Posterior pole view; 2228x1652px; color fundus photograph.
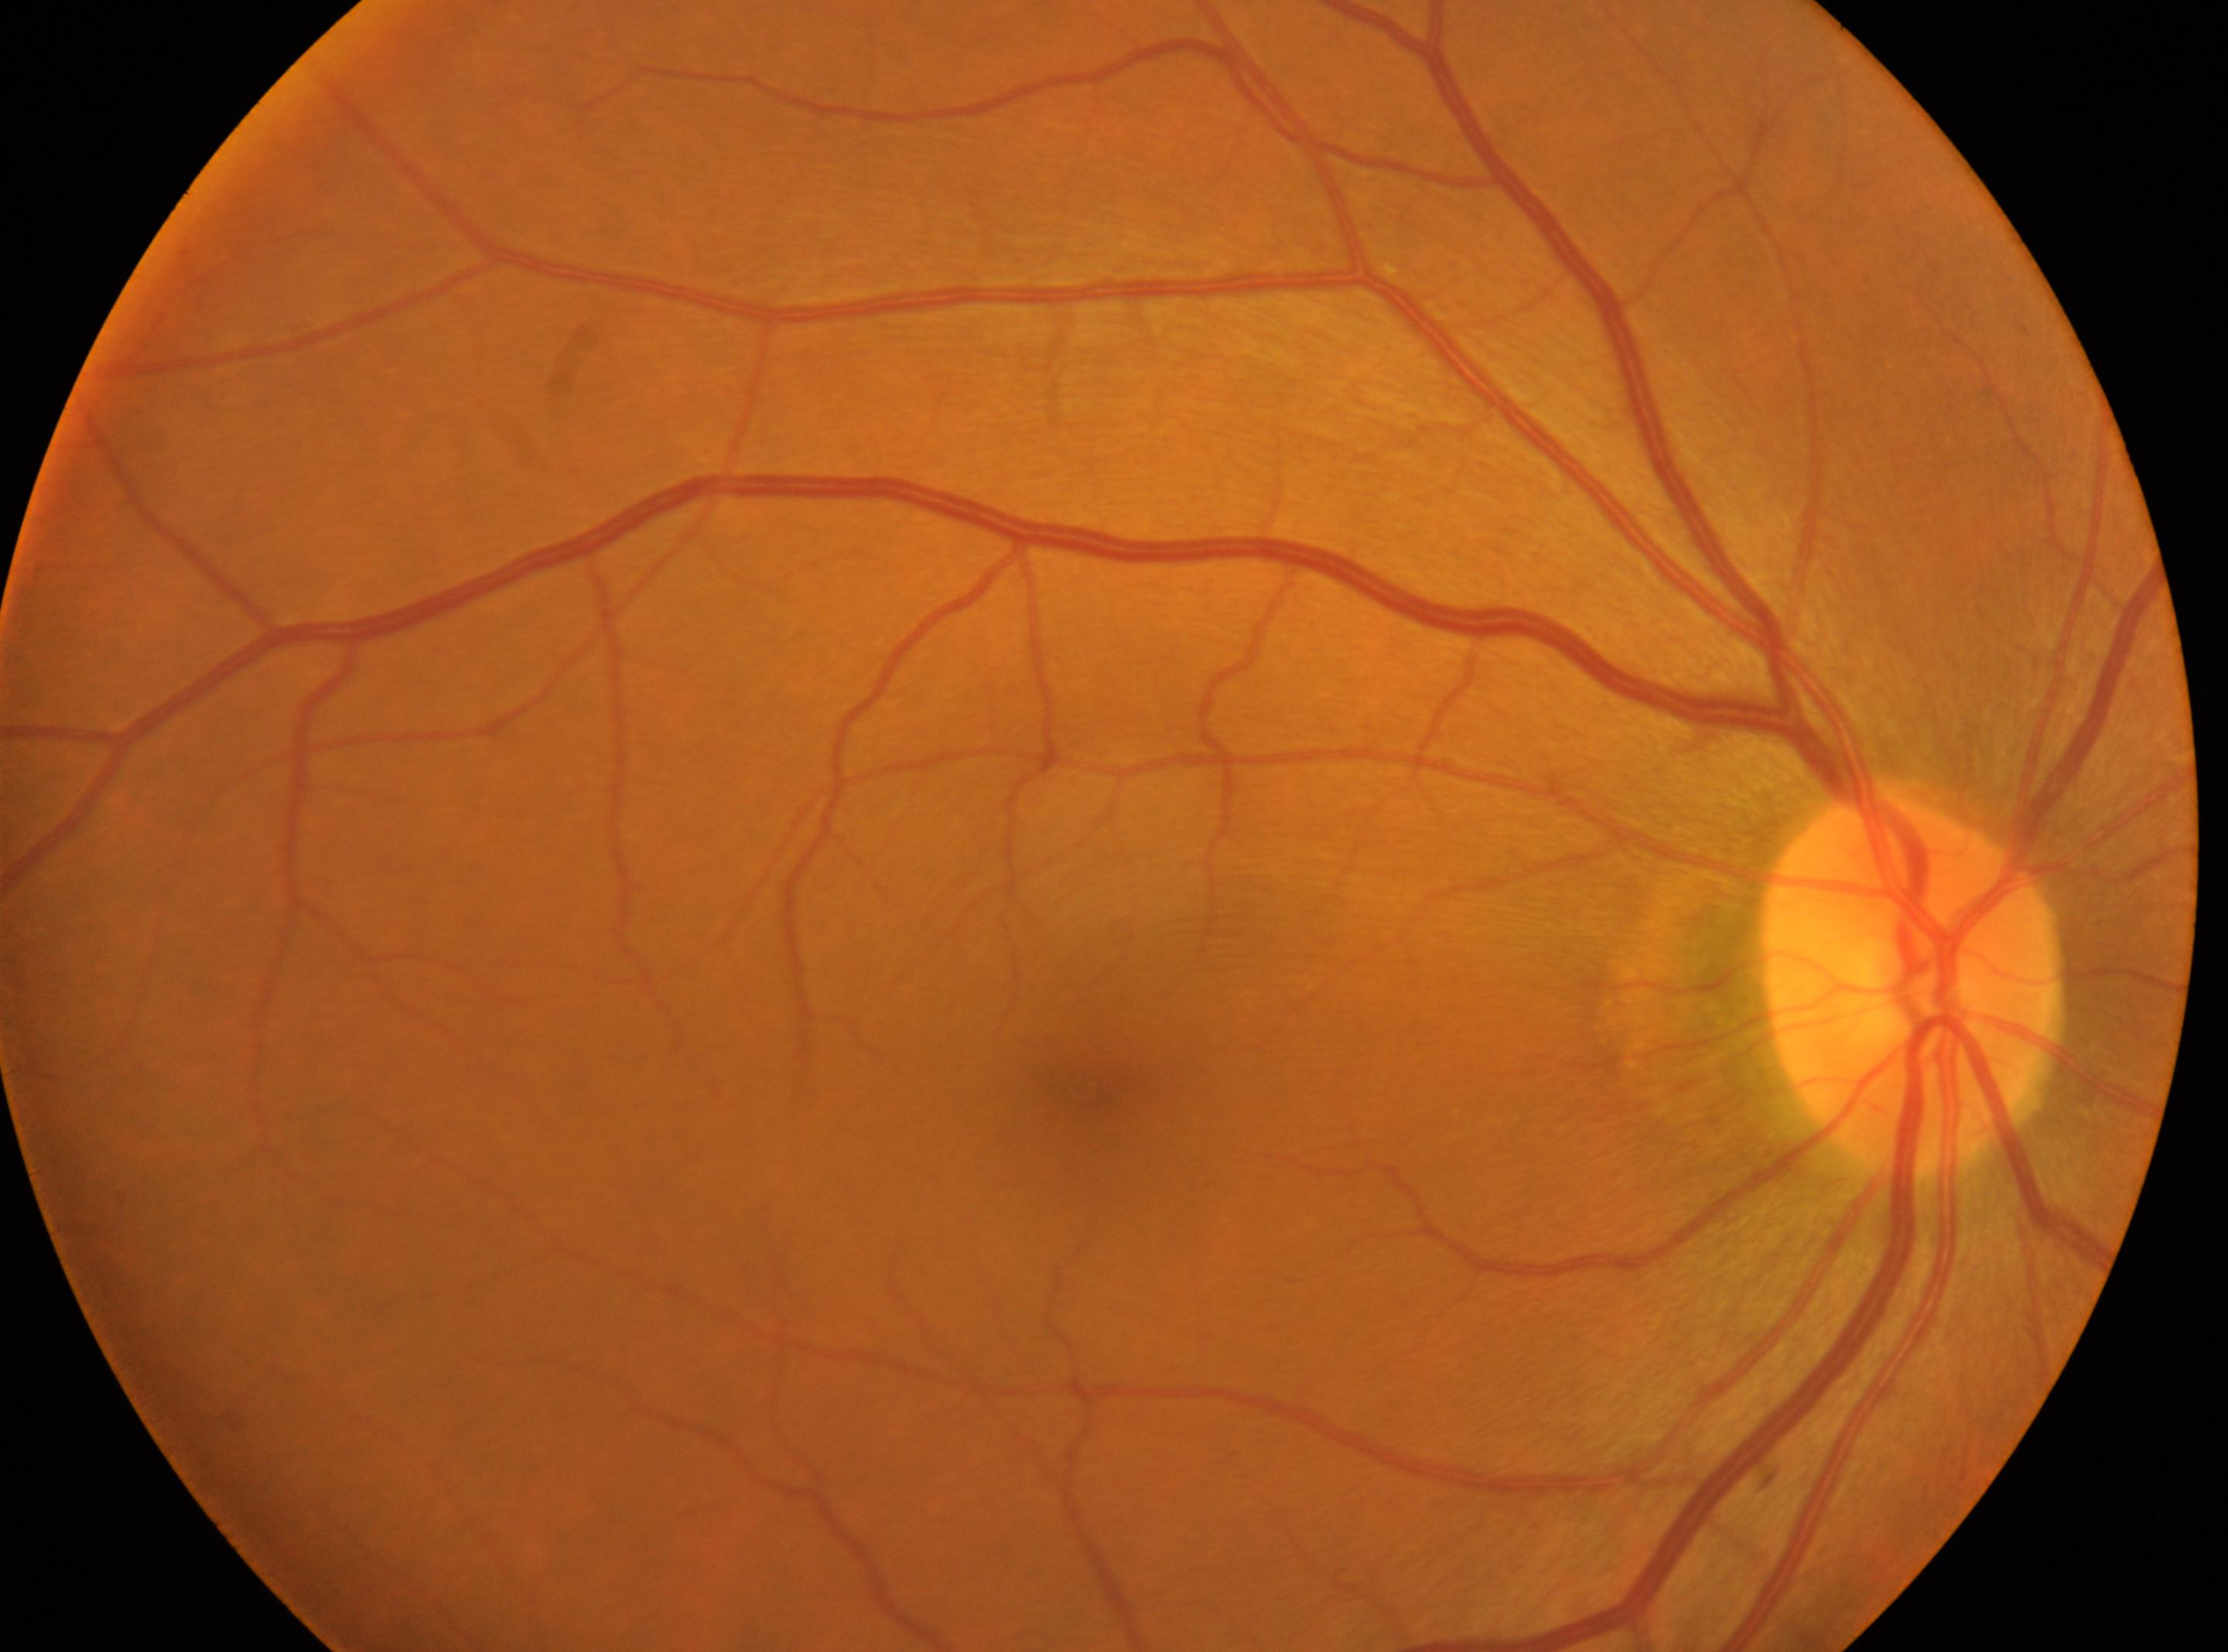
The image shows the right eye.
Diabetic retinopathy (DR) is grade 0 (no apparent retinopathy).
Fovea: (x=1082, y=1089).
The disc center is at (x=1912, y=988).